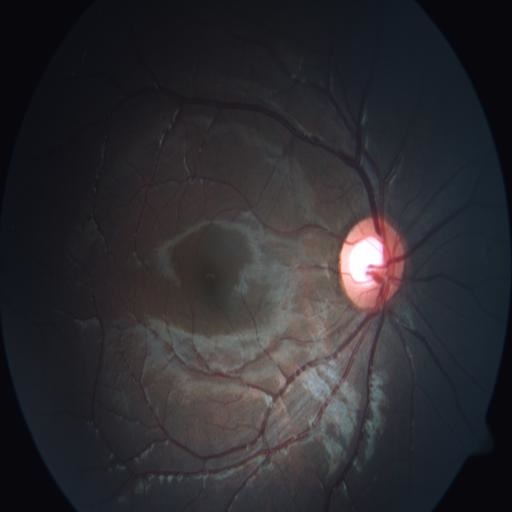
There is evidence of ODC (optic disc cupping).